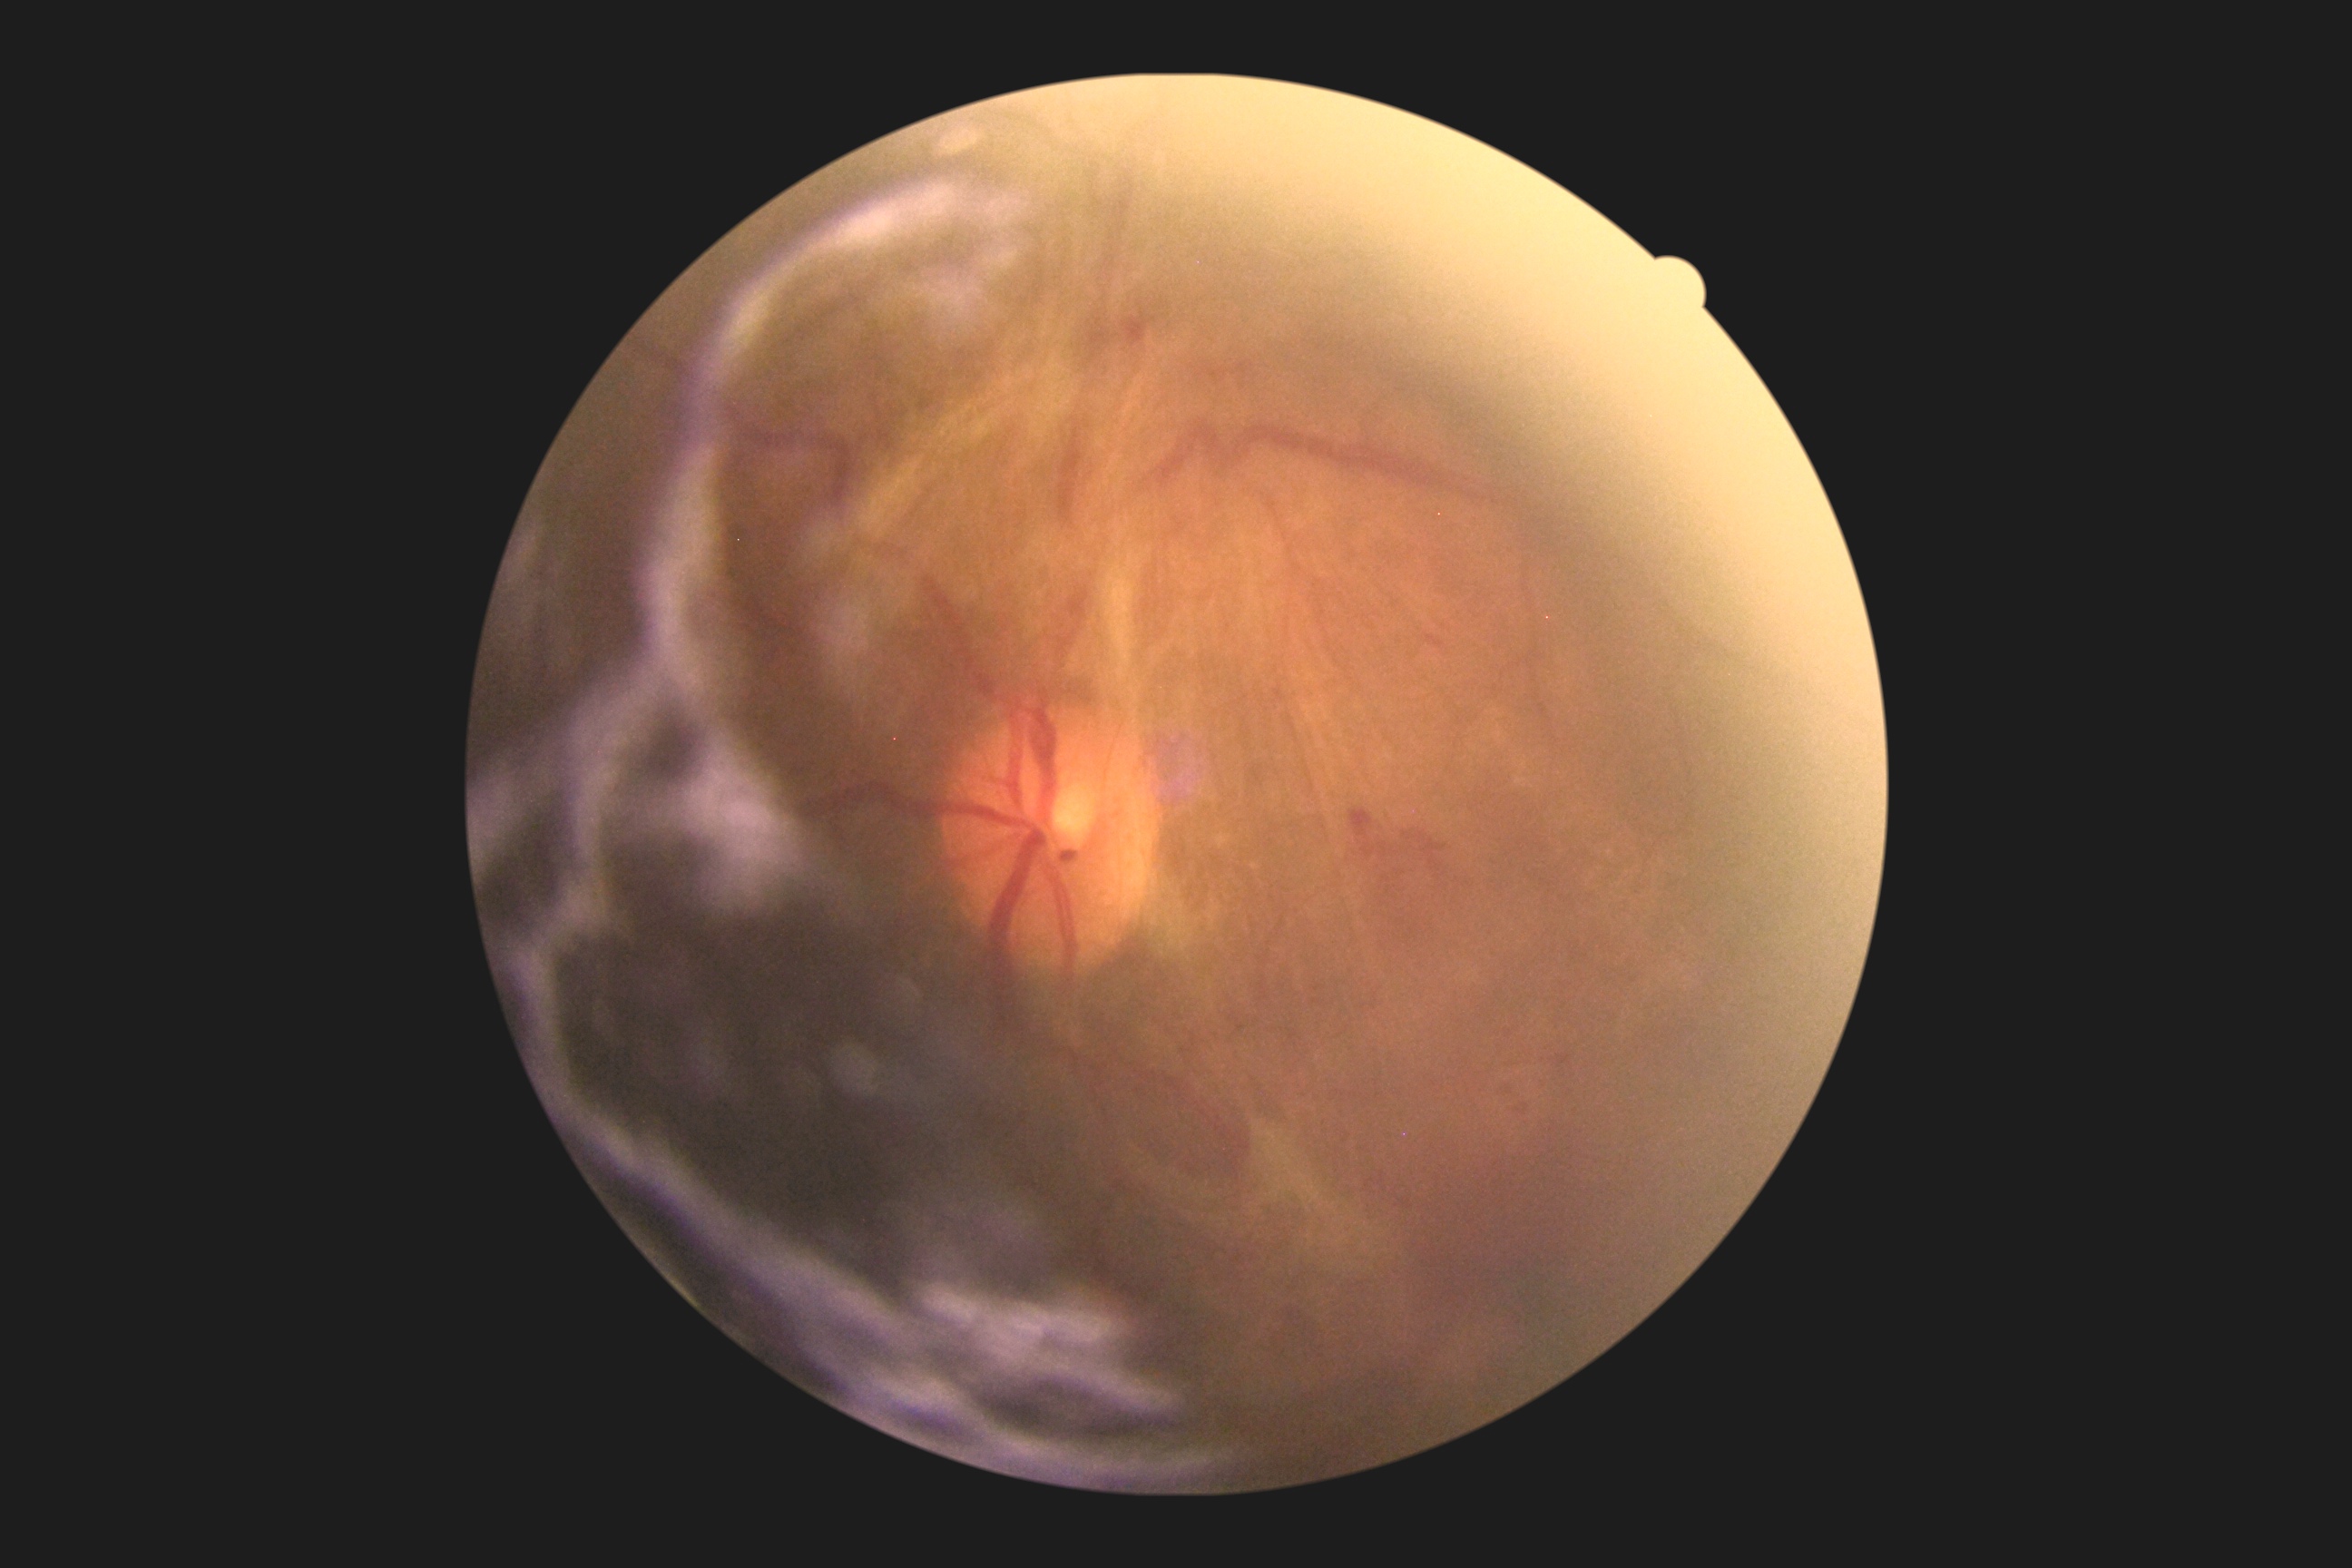
DR class: proliferative diabetic retinopathy | diabetic retinopathy (DR): proliferative diabetic retinopathy (grade 4).